FOV: 45 degrees. Diabetic retinopathy graded by the modified Davis classification. NIDEK AFC-230 fundus camera. Nonmydriatic fundus photograph
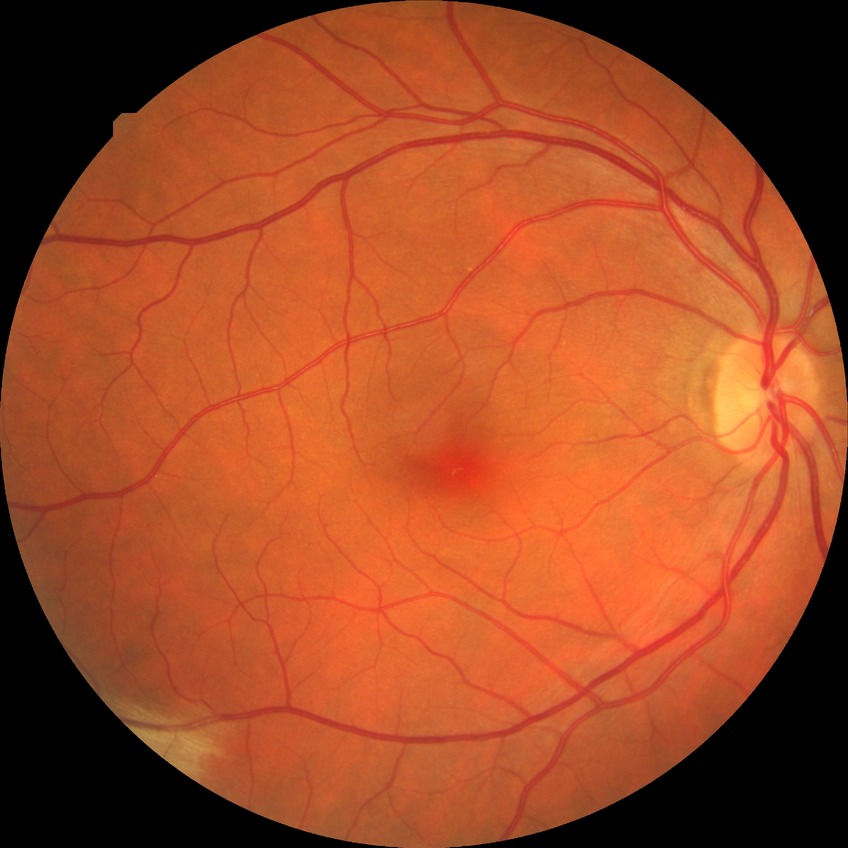 diabetic retinopathy (DR): NDR (no diabetic retinopathy).